1932x1932. 45° field of view: 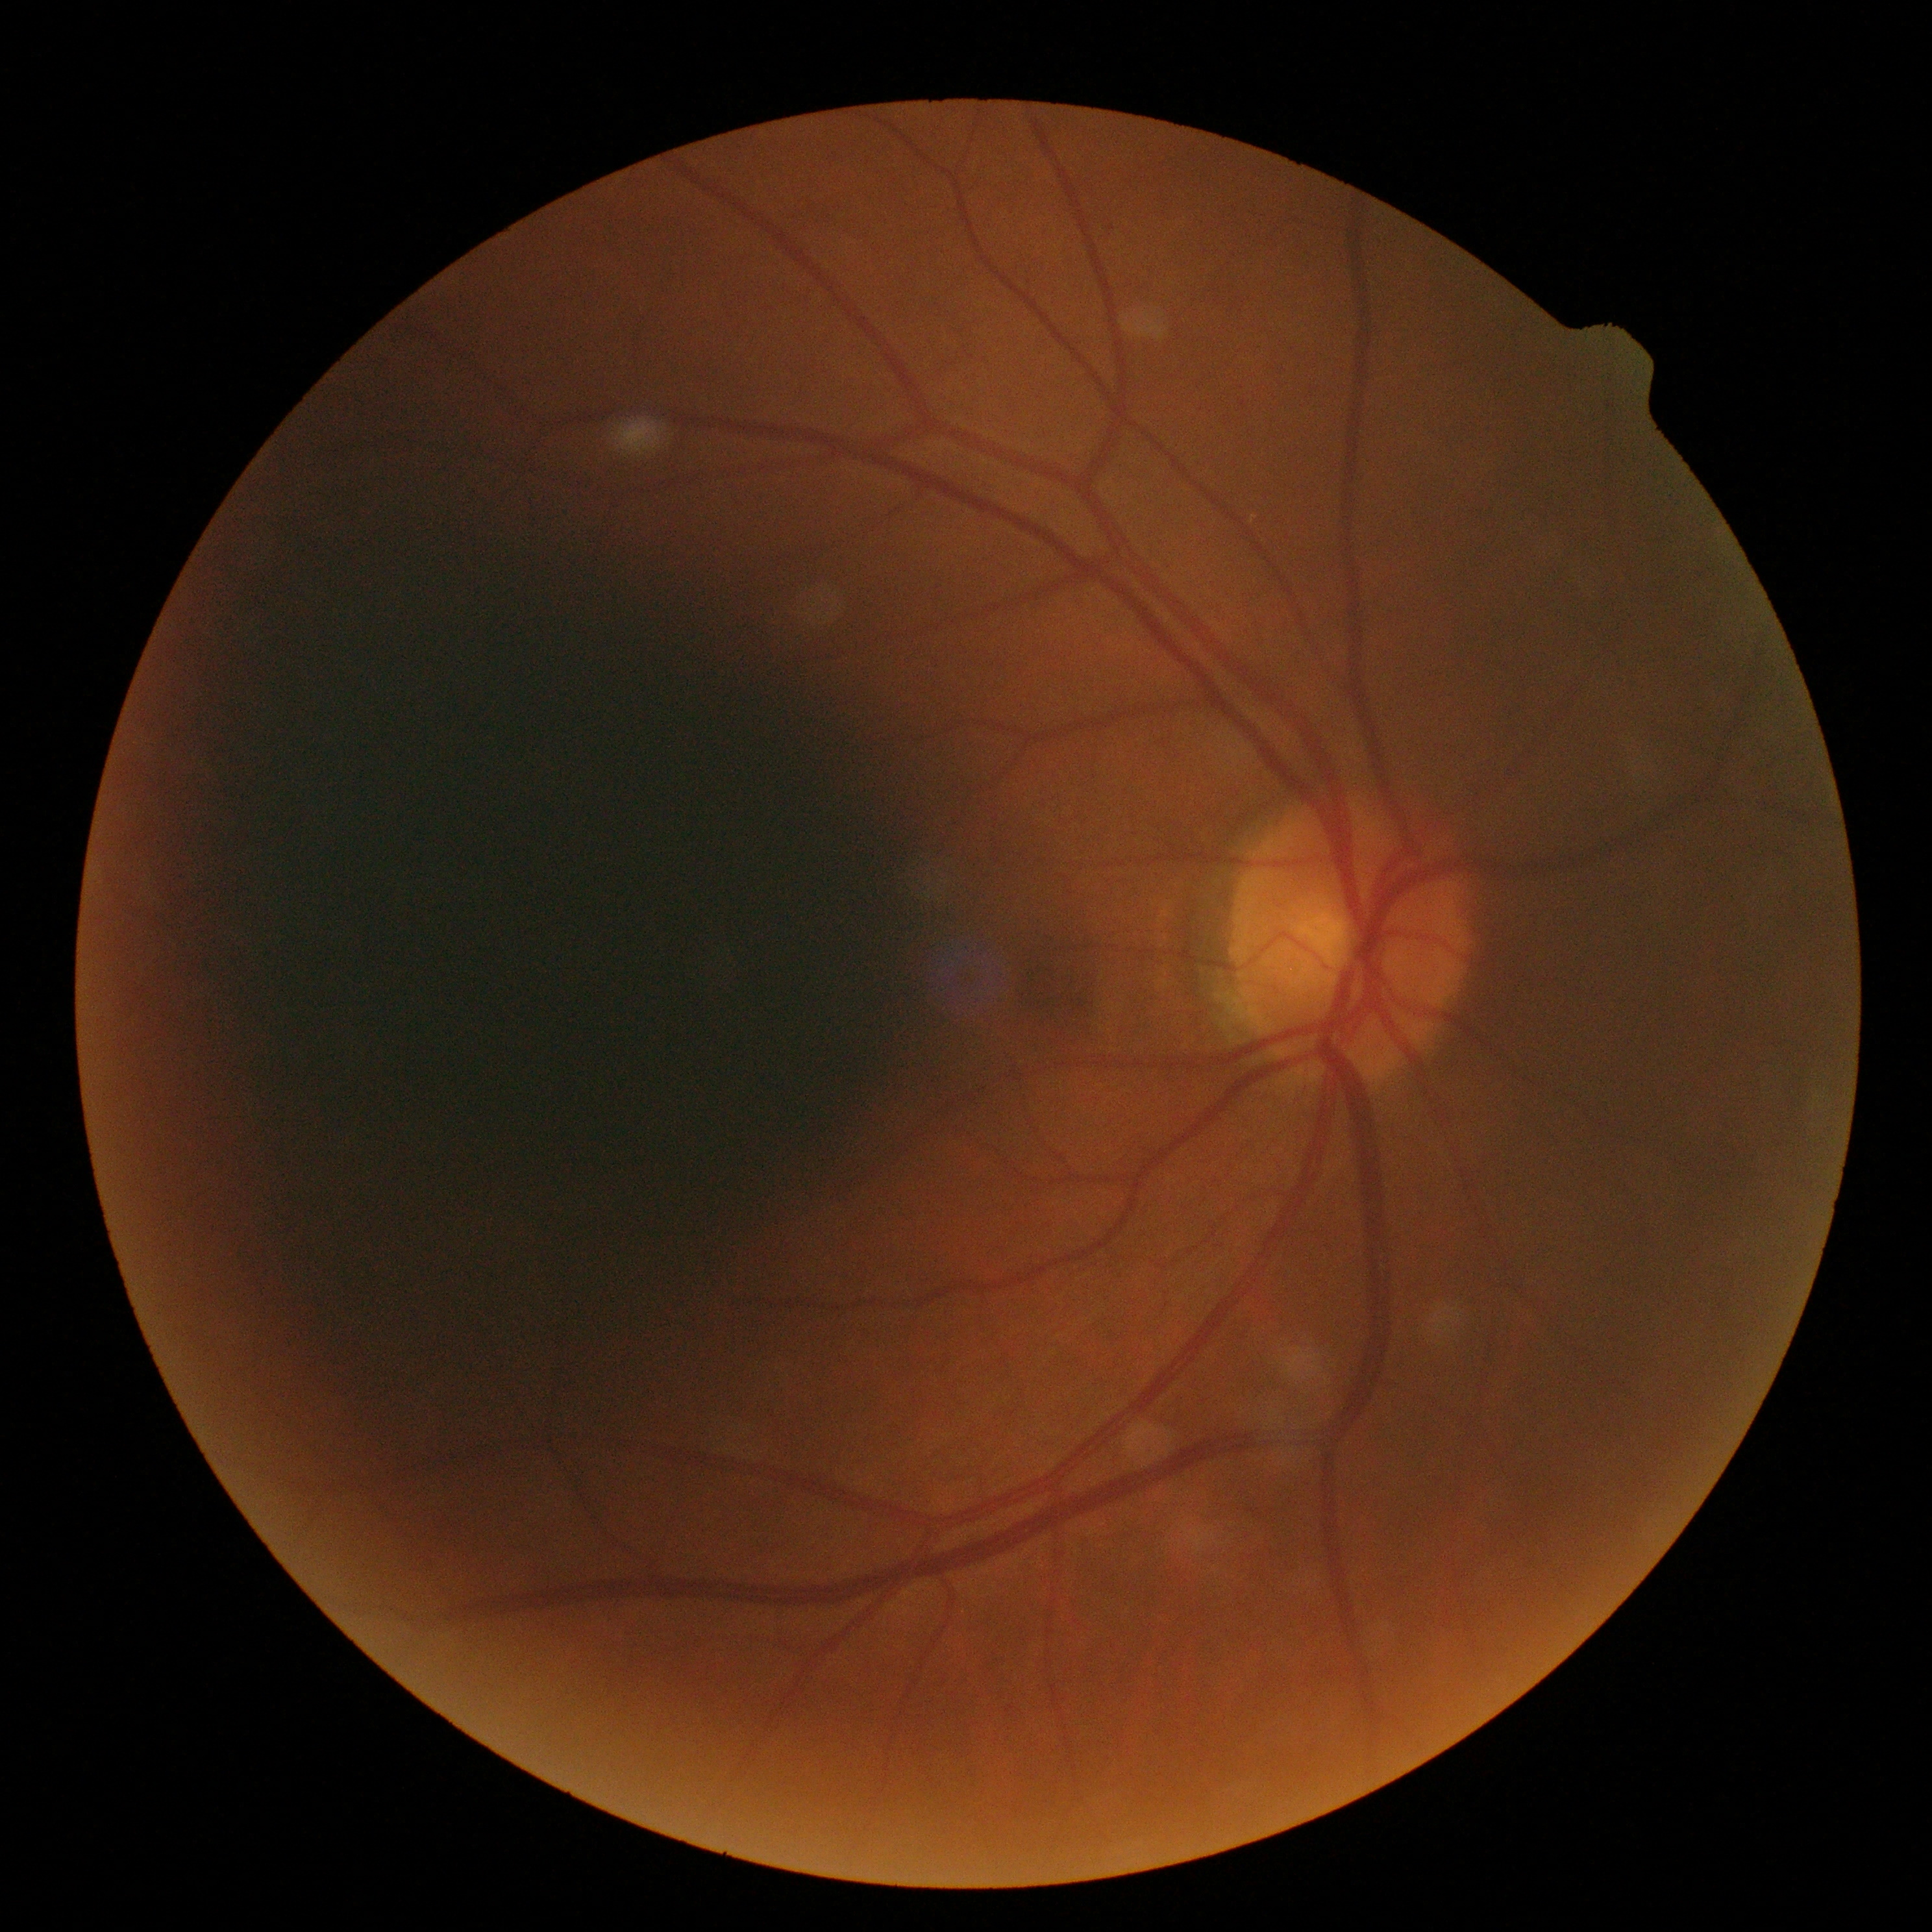

DR severity@grade 0.